FOV: 200 degrees.
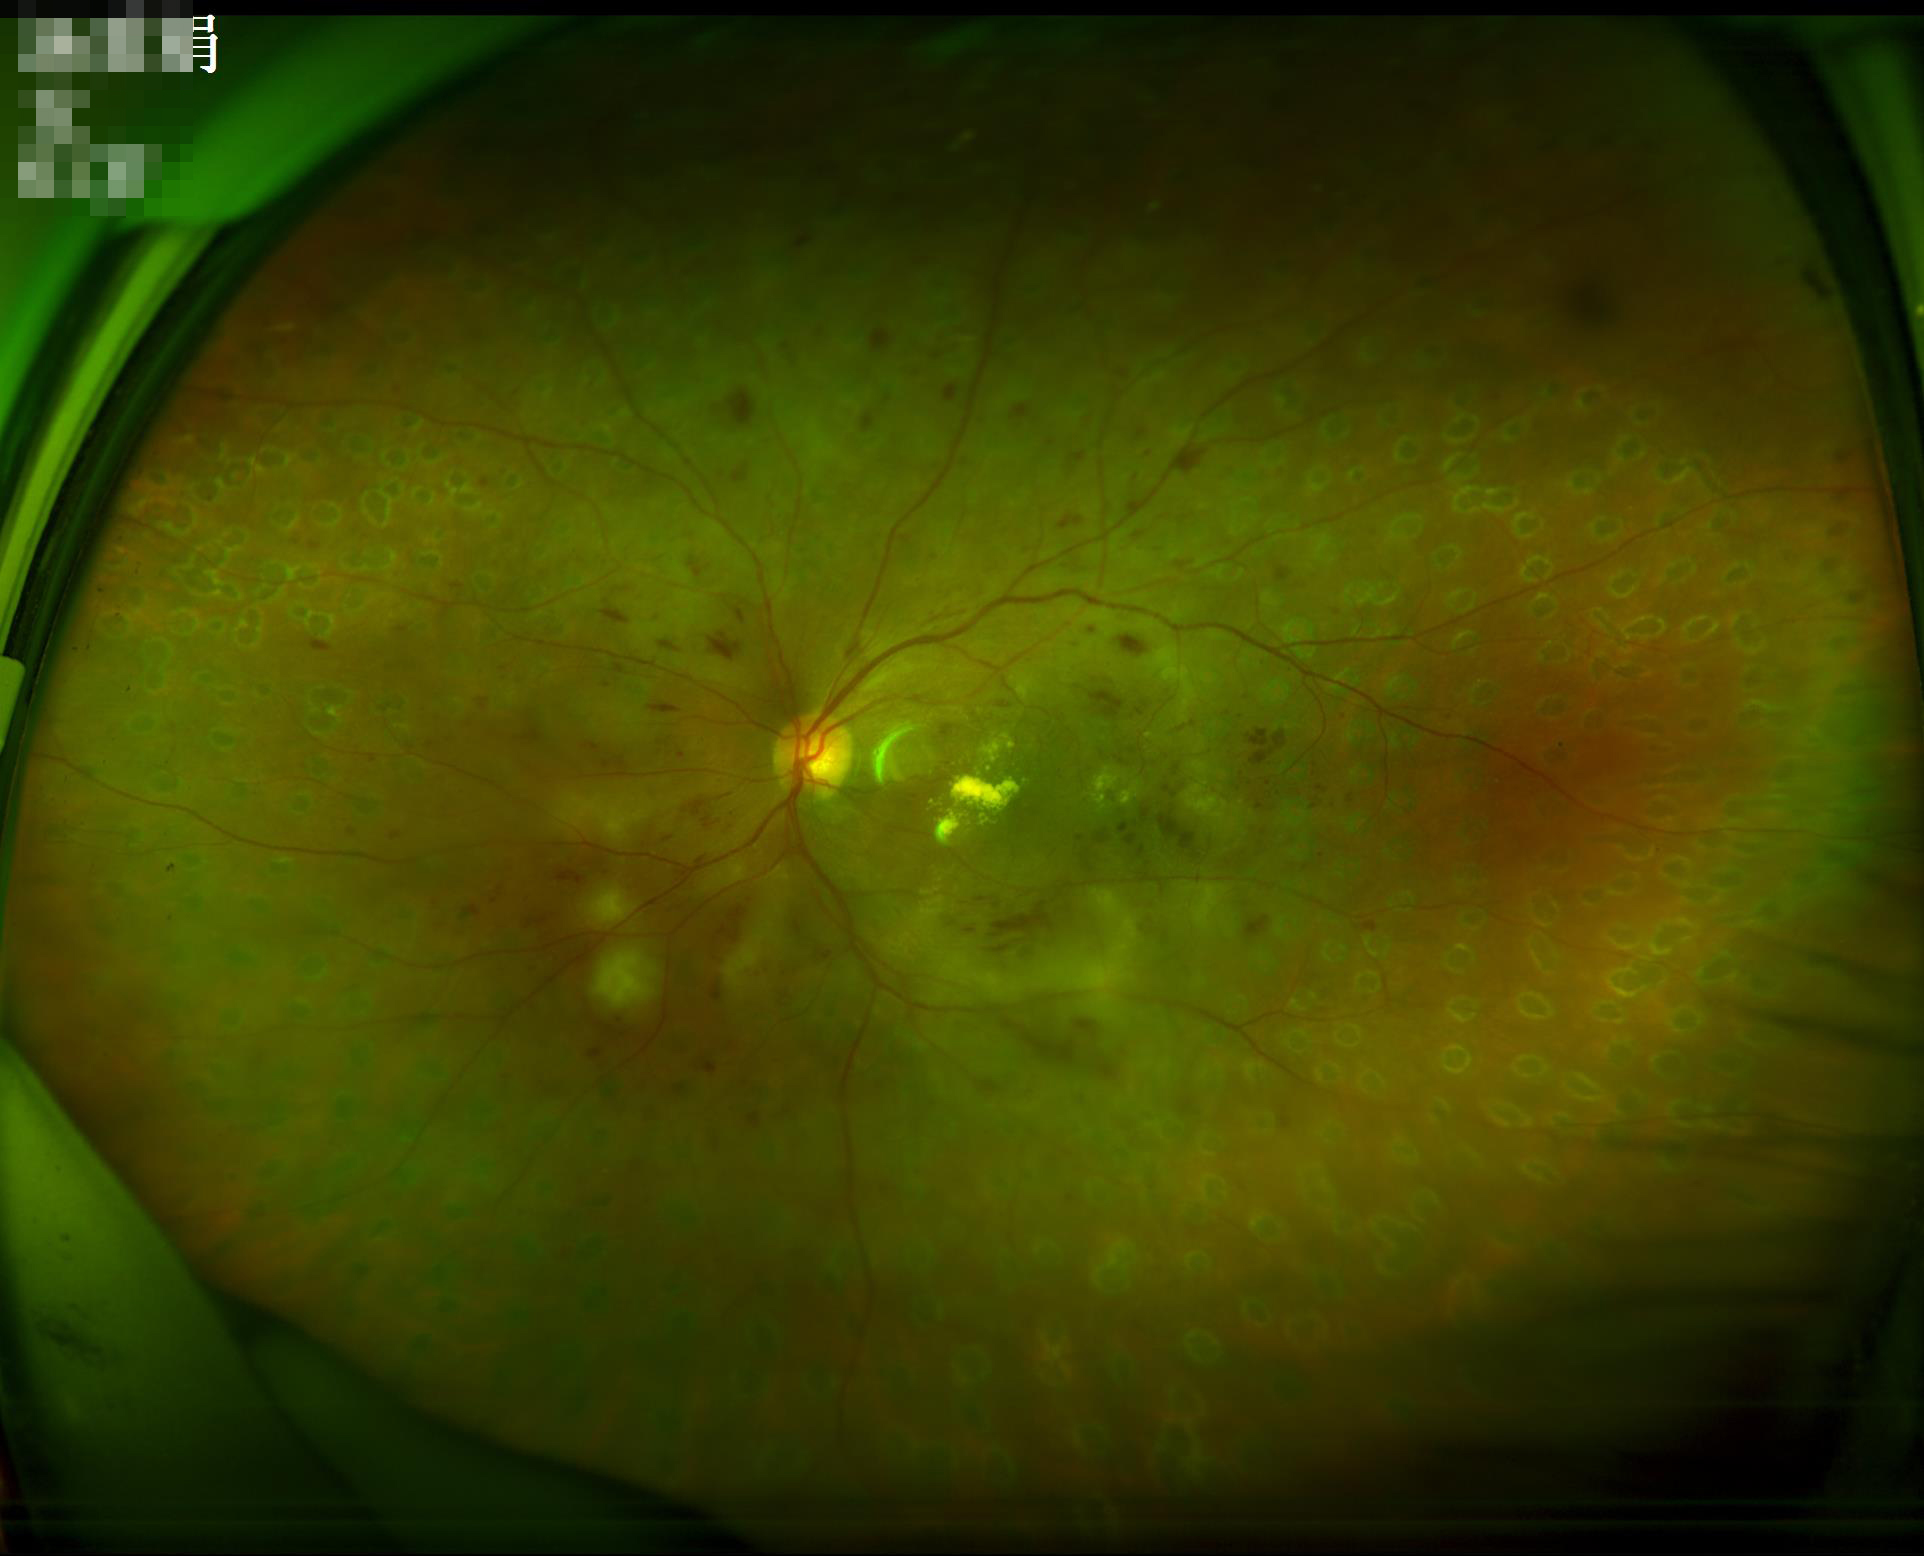 Contrast: vessels and details readily distinguishable; Illumination/color: no over- or under-exposure; Sharpness: sharp throughout the field; Overall image quality: adequate for clinical interpretation.